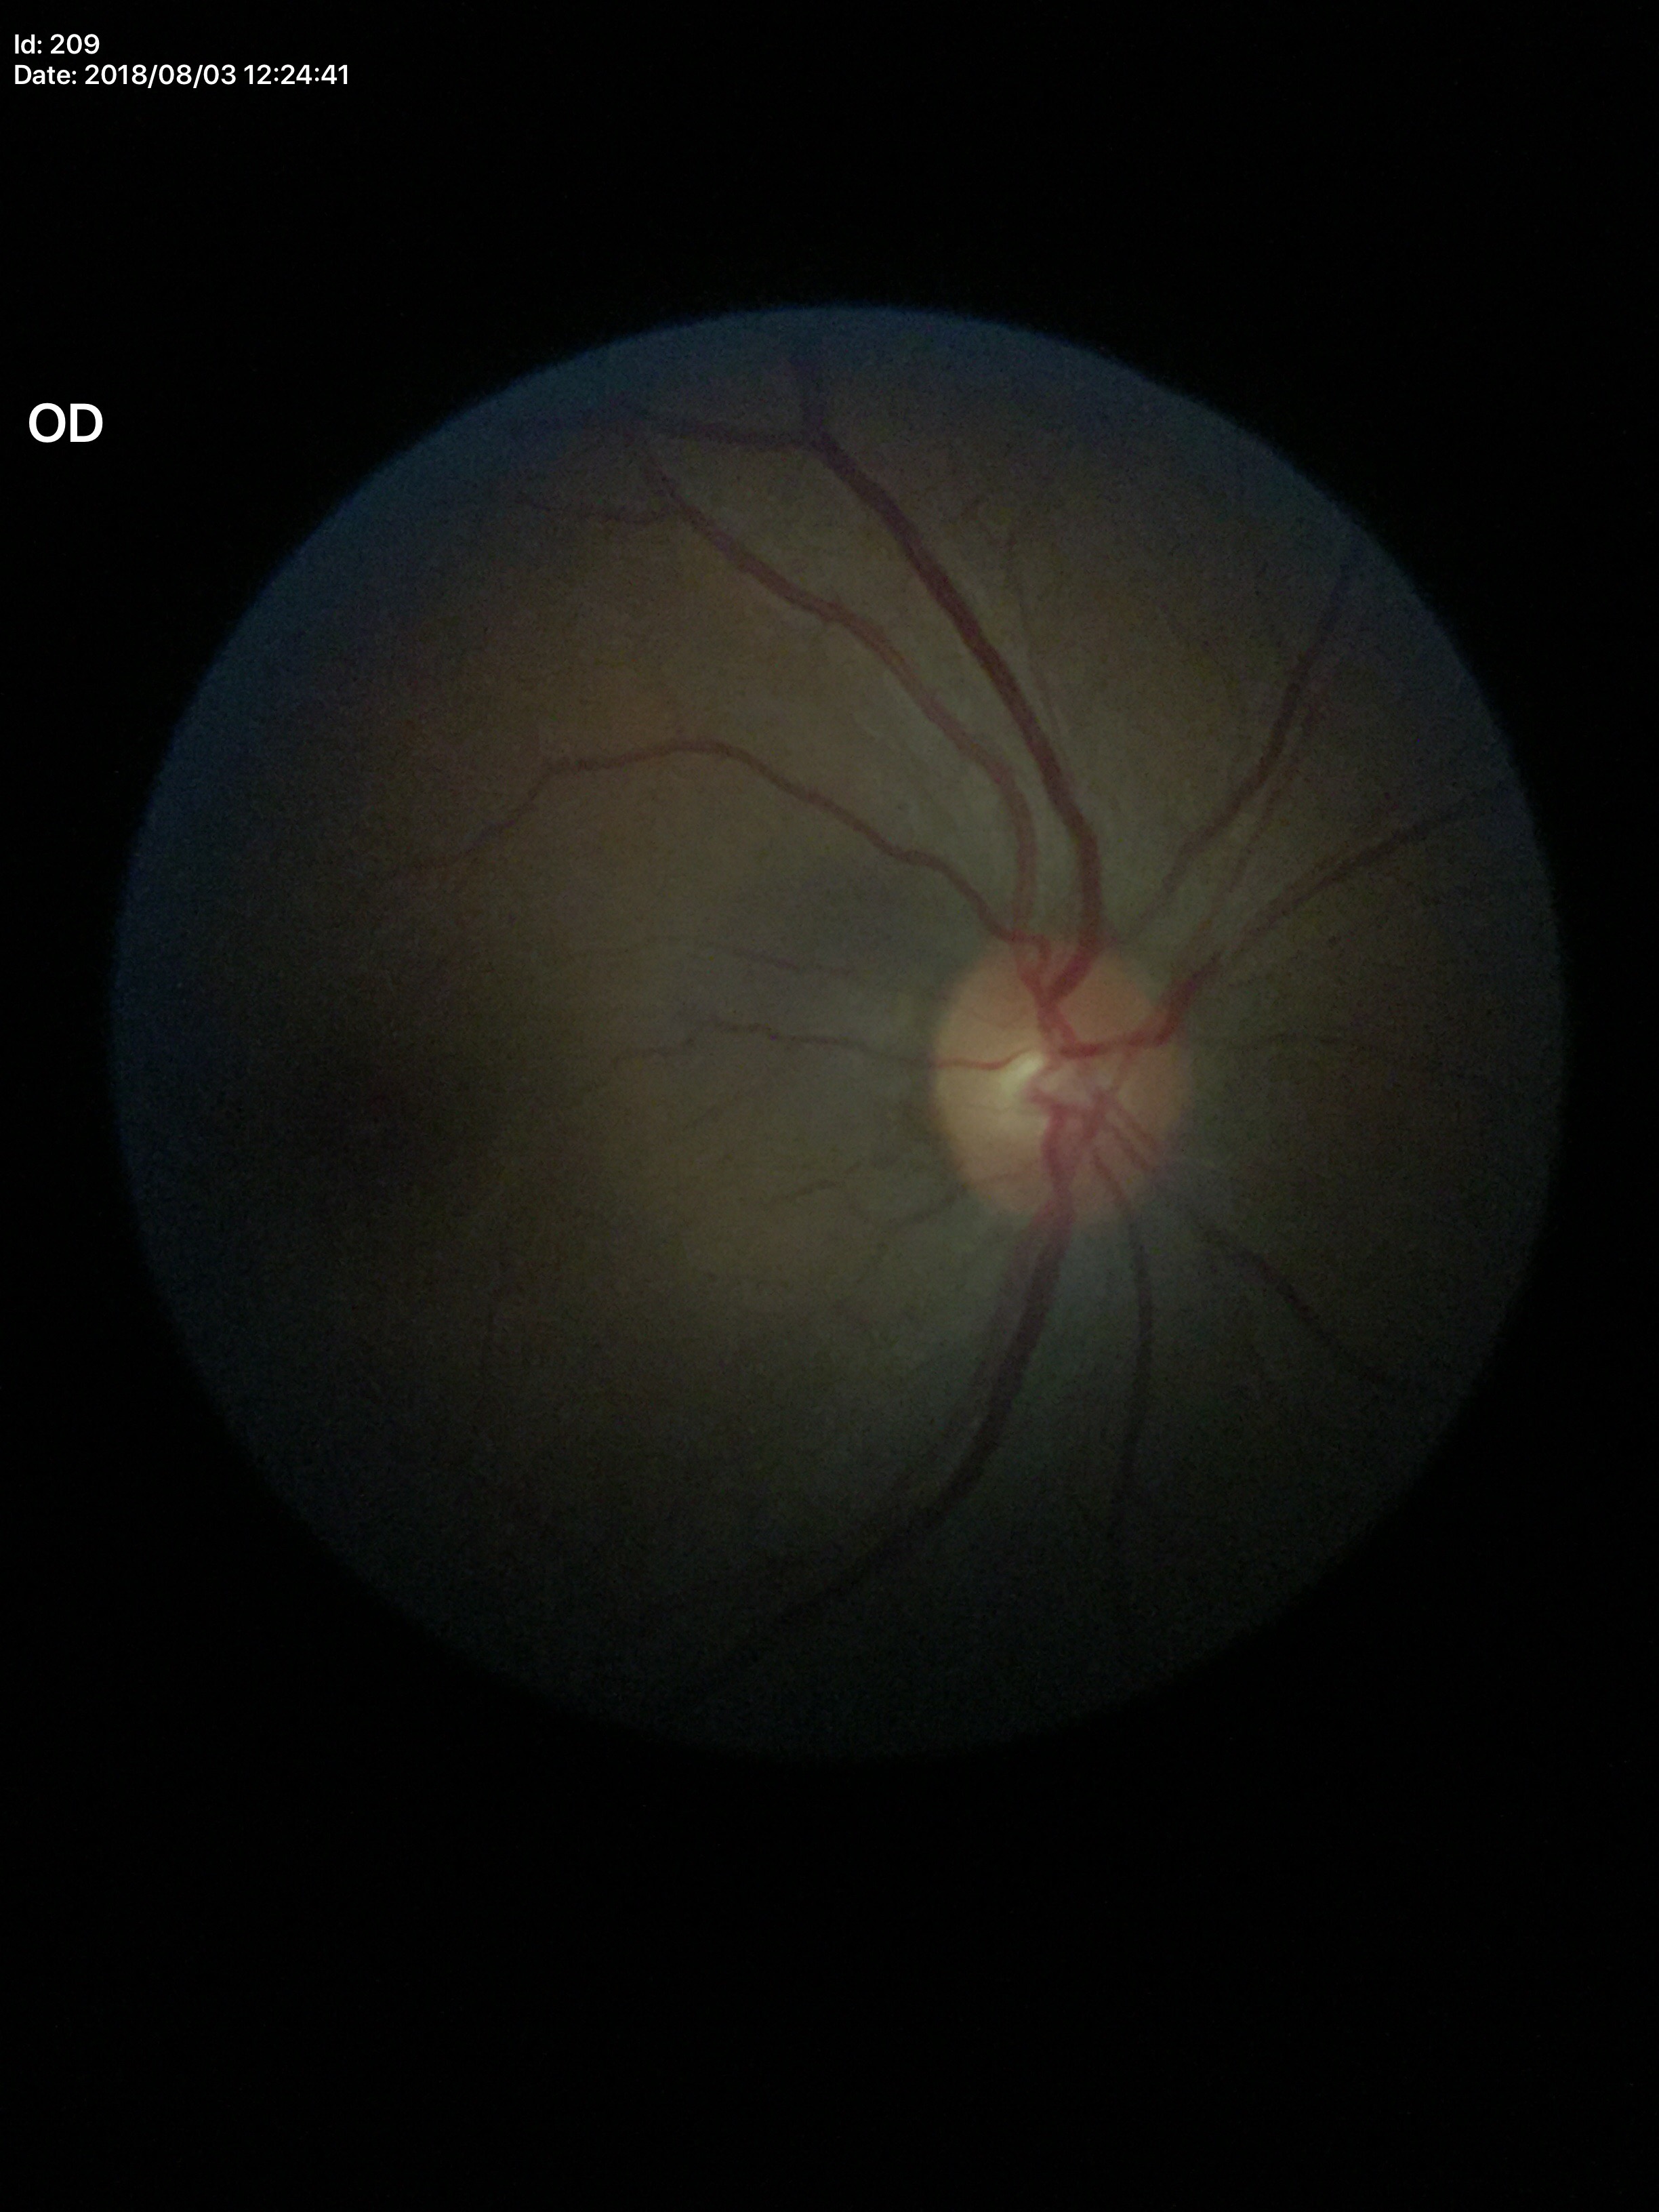 Findings:
- Glaucoma evaluation: no suspicious findings
- HCDR: 0.50
- VCDR: 0.42